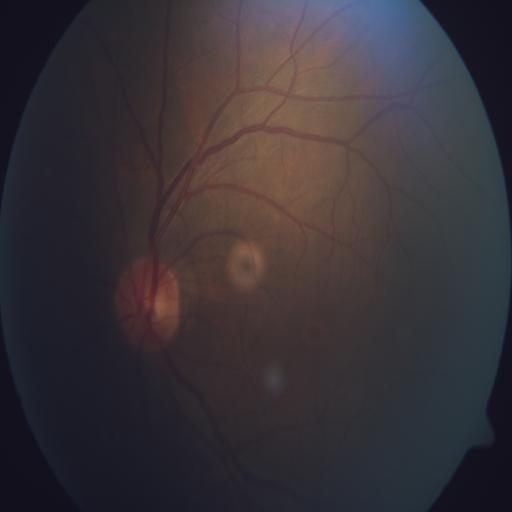
No retinal pathology identified.